No pharmacologic dilation — 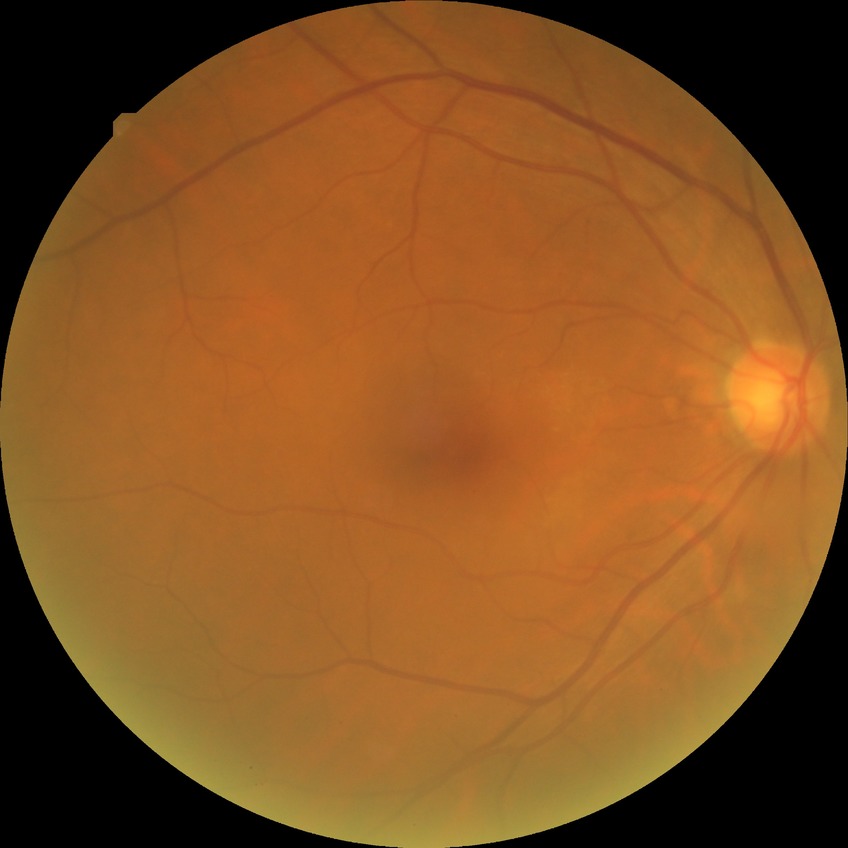 Diabetic retinopathy (DR) is no diabetic retinopathy (NDR).